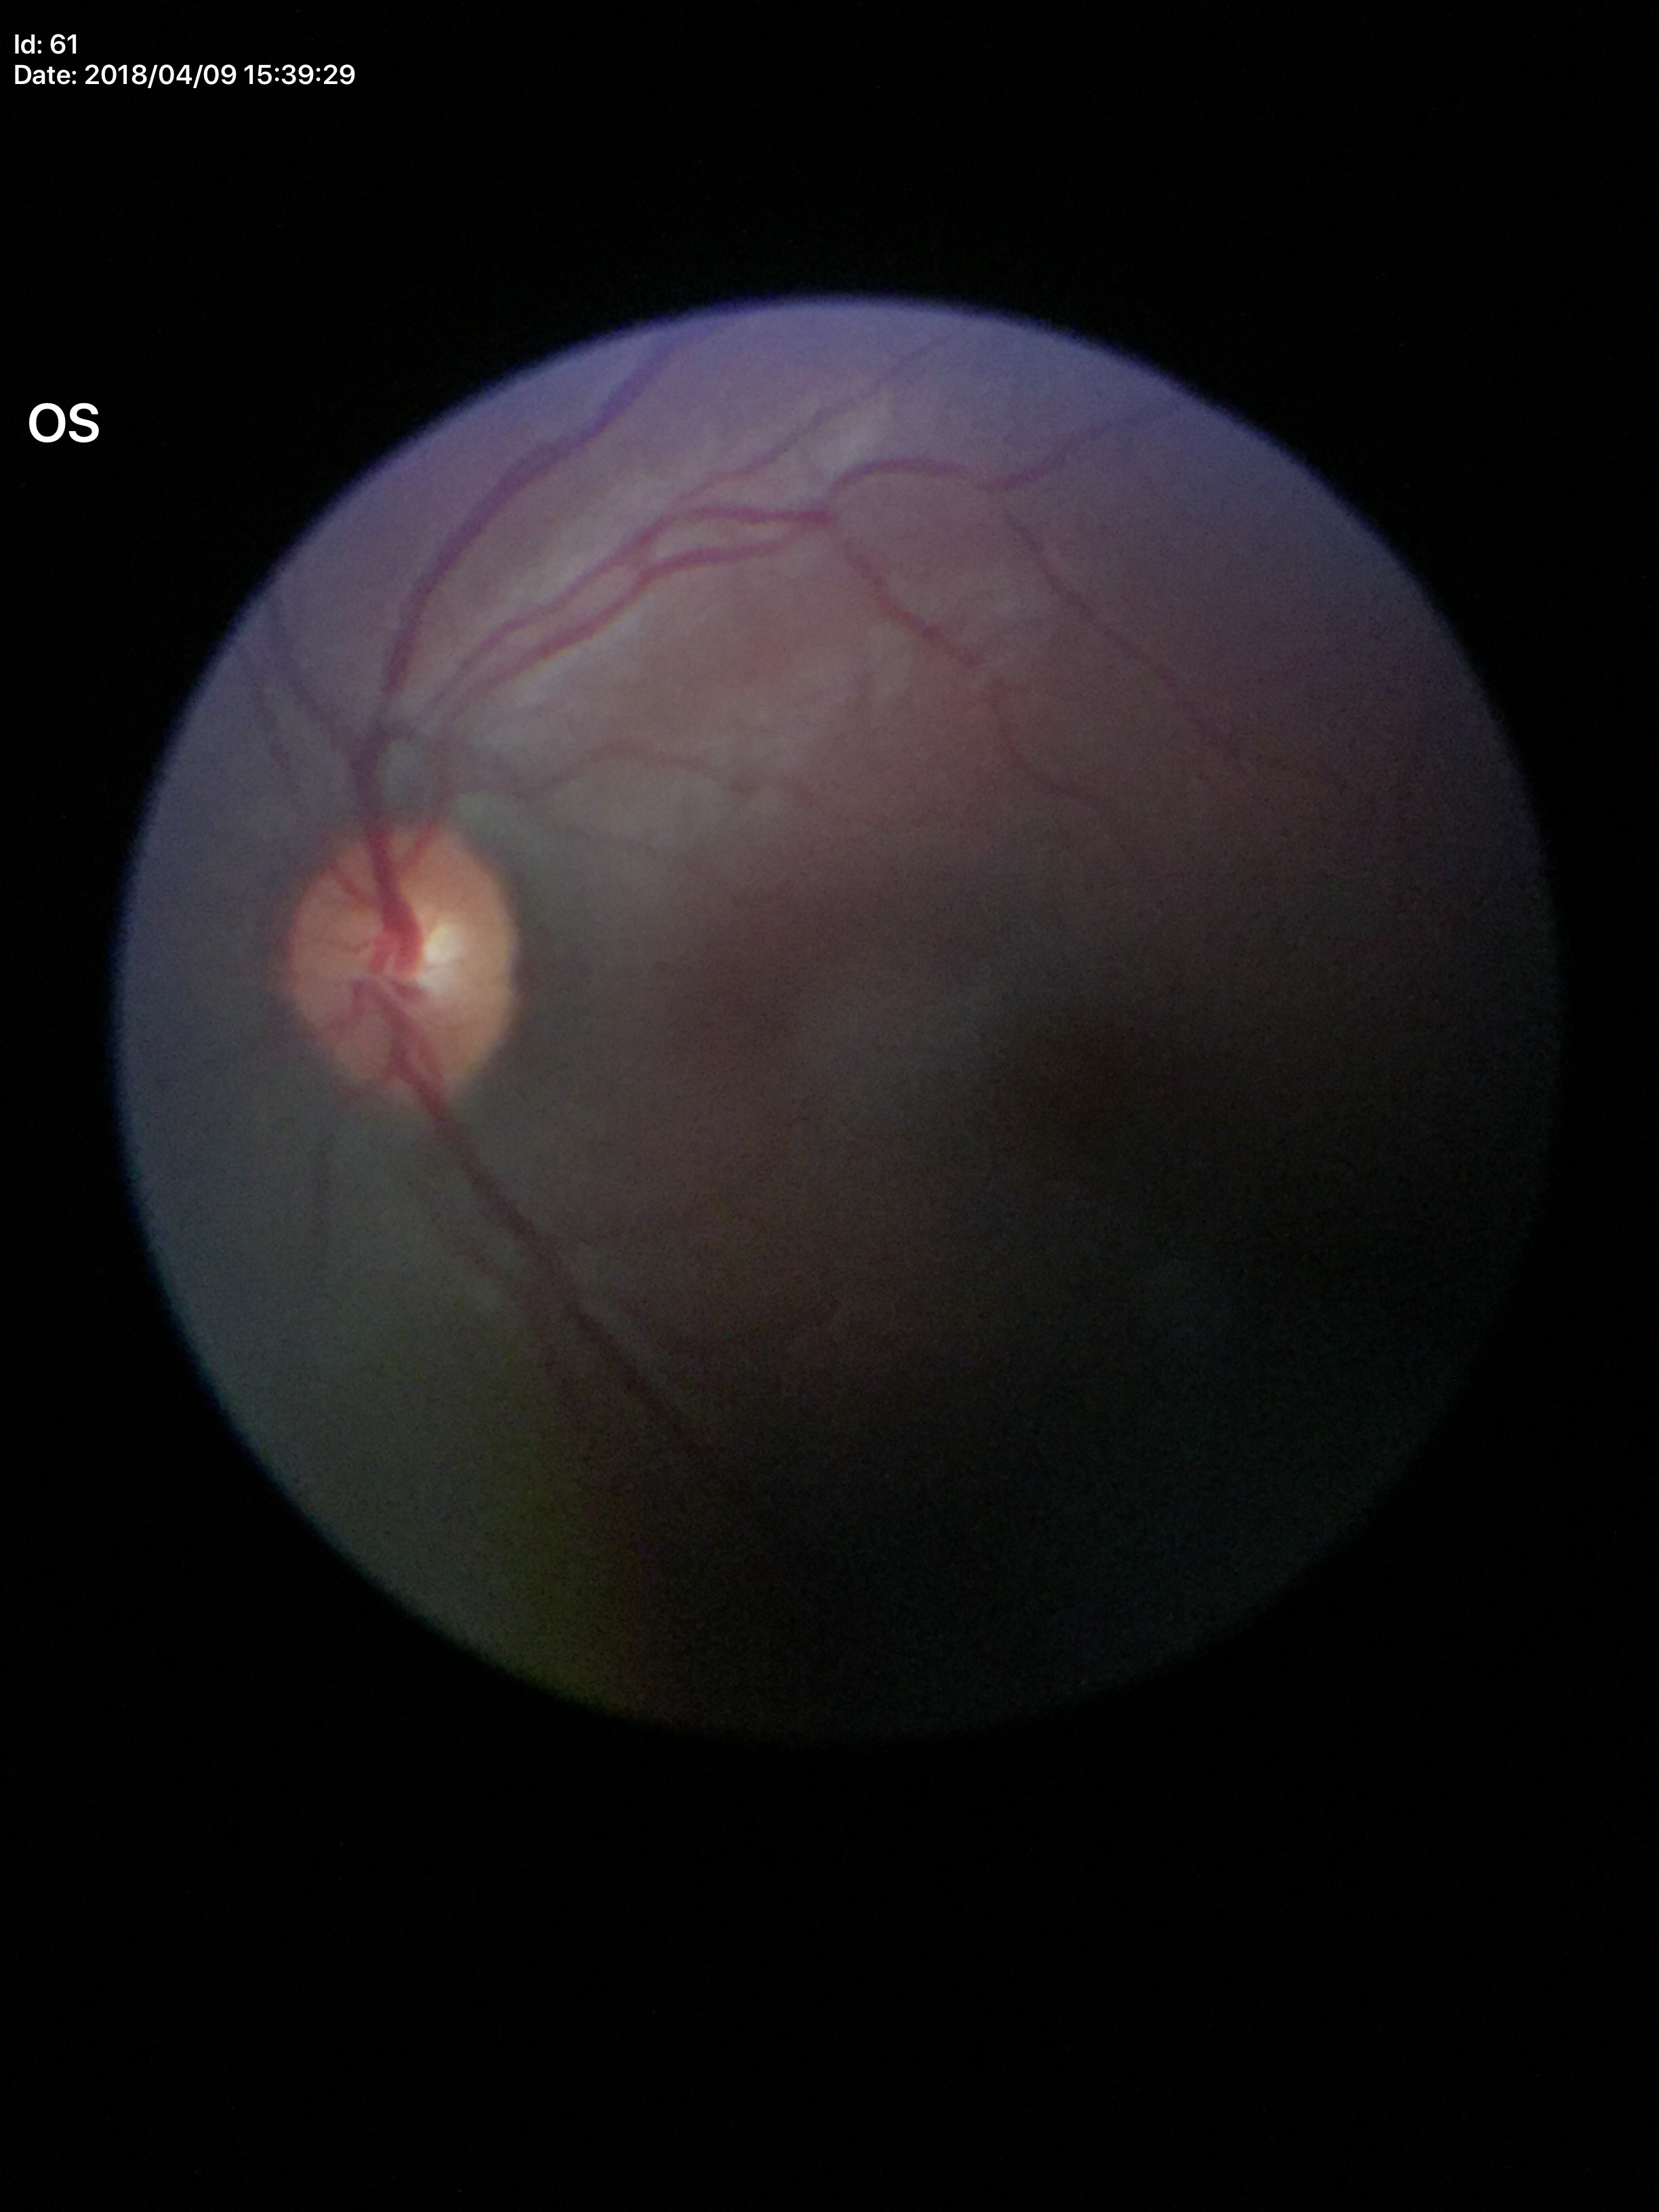
No evidence of glaucoma. Vertical CDR of 0.47.